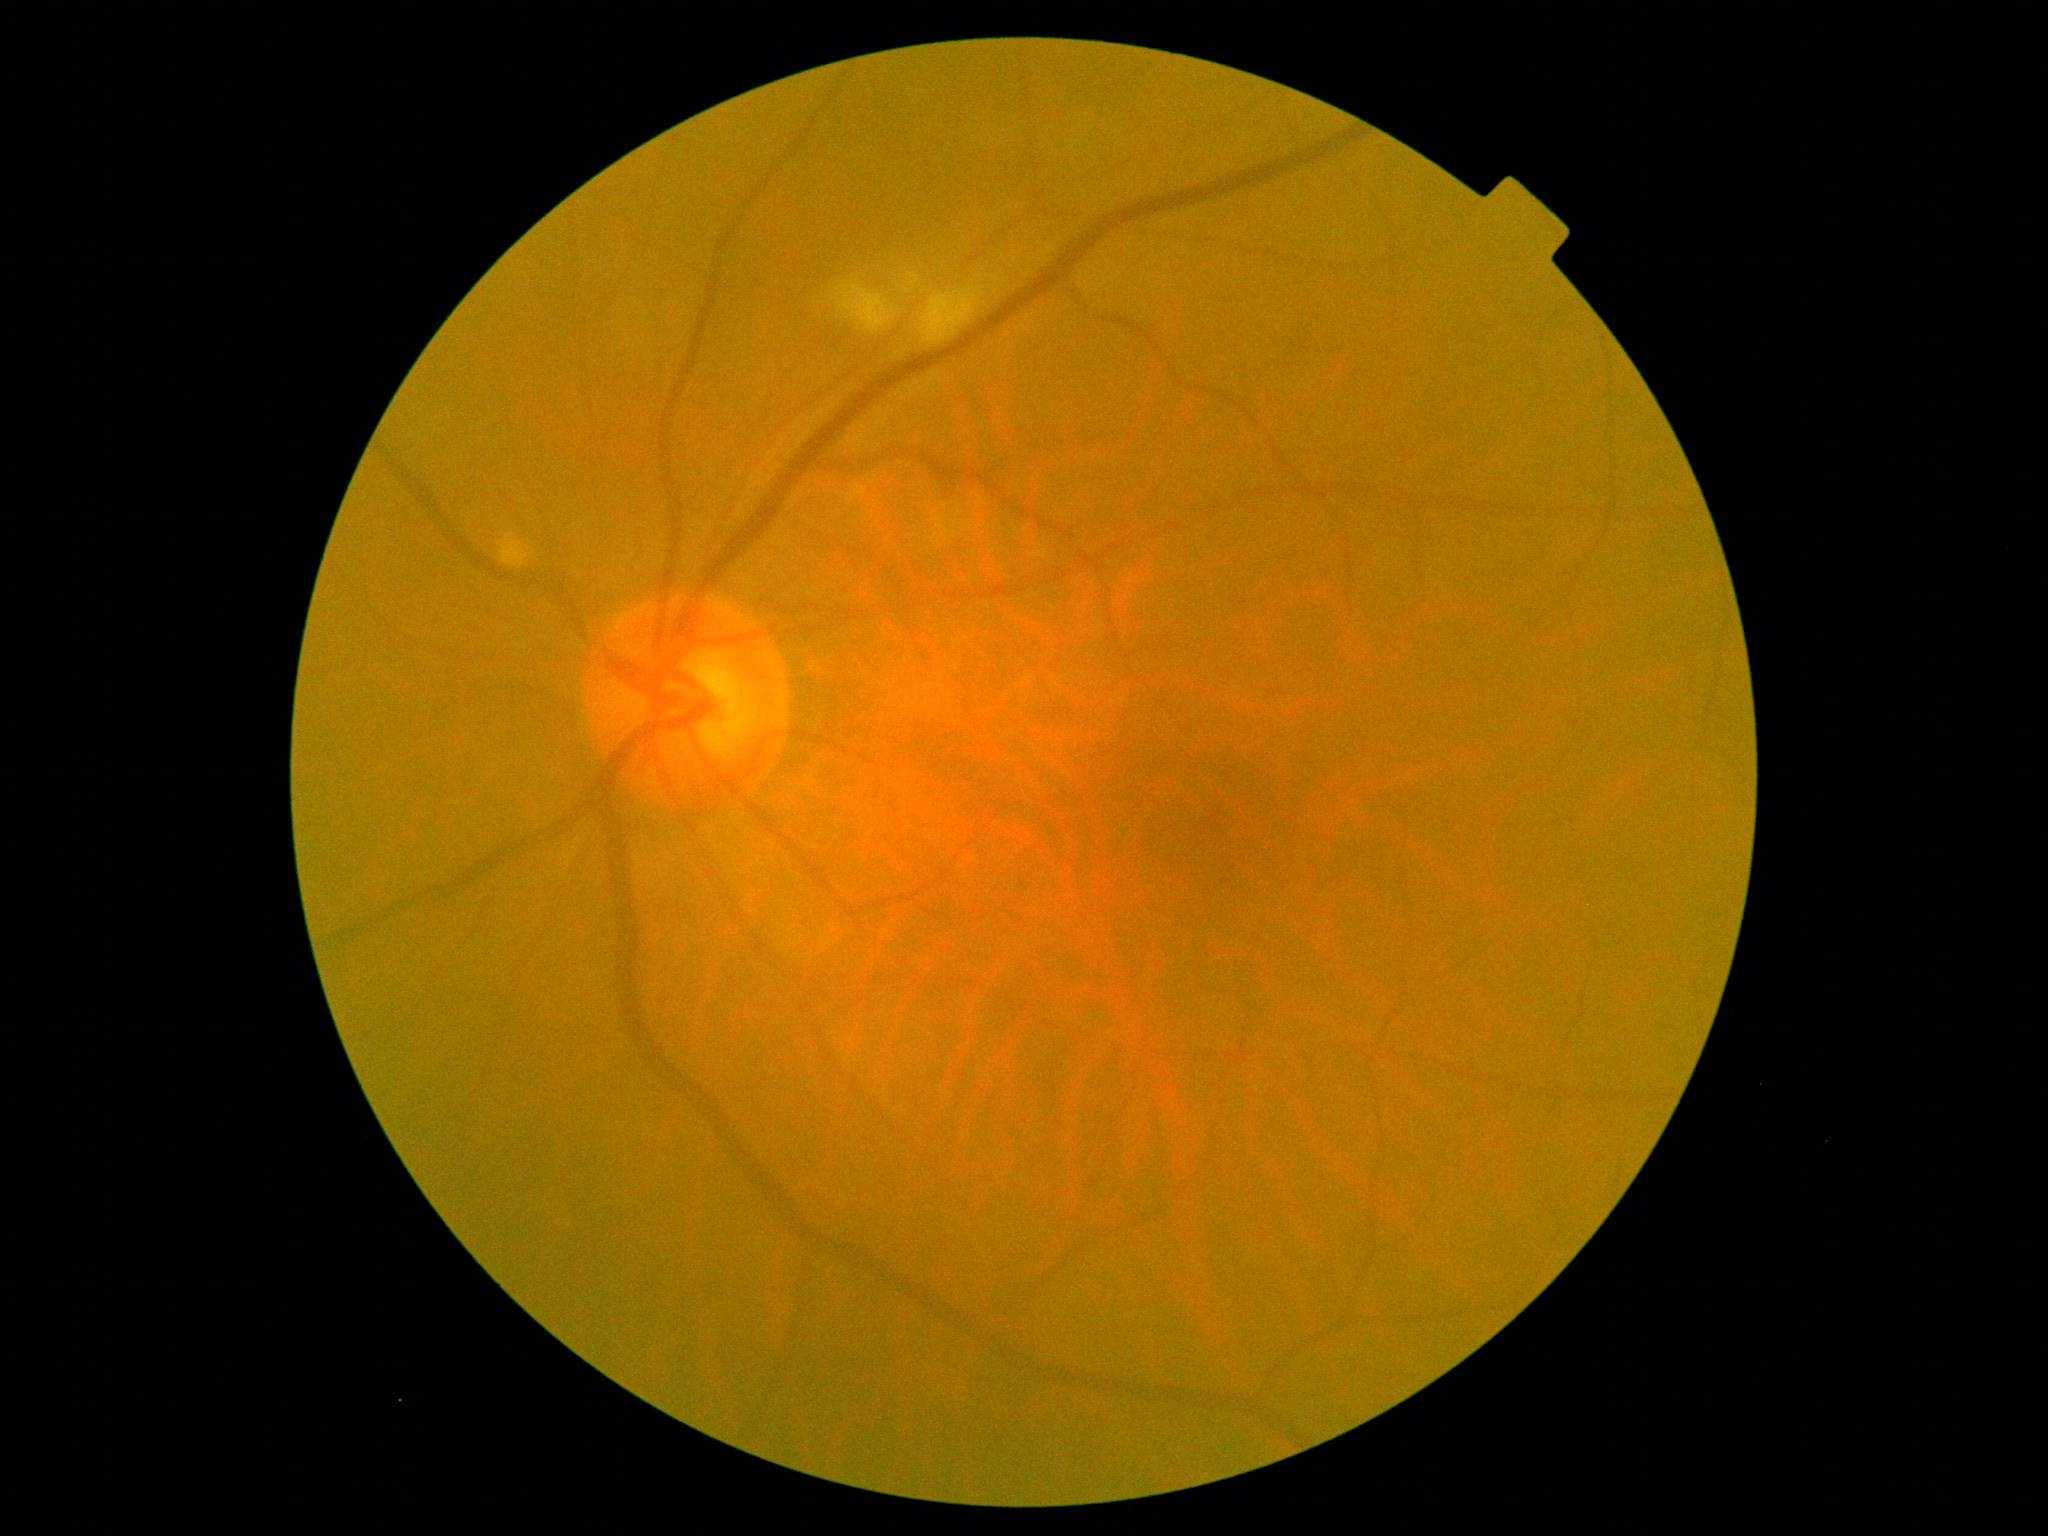
DR grade is 2 (moderate NPDR). The retinopathy is classified as non-proliferative diabetic retinopathy.